Phoenix ICON wide-field infant fundus image
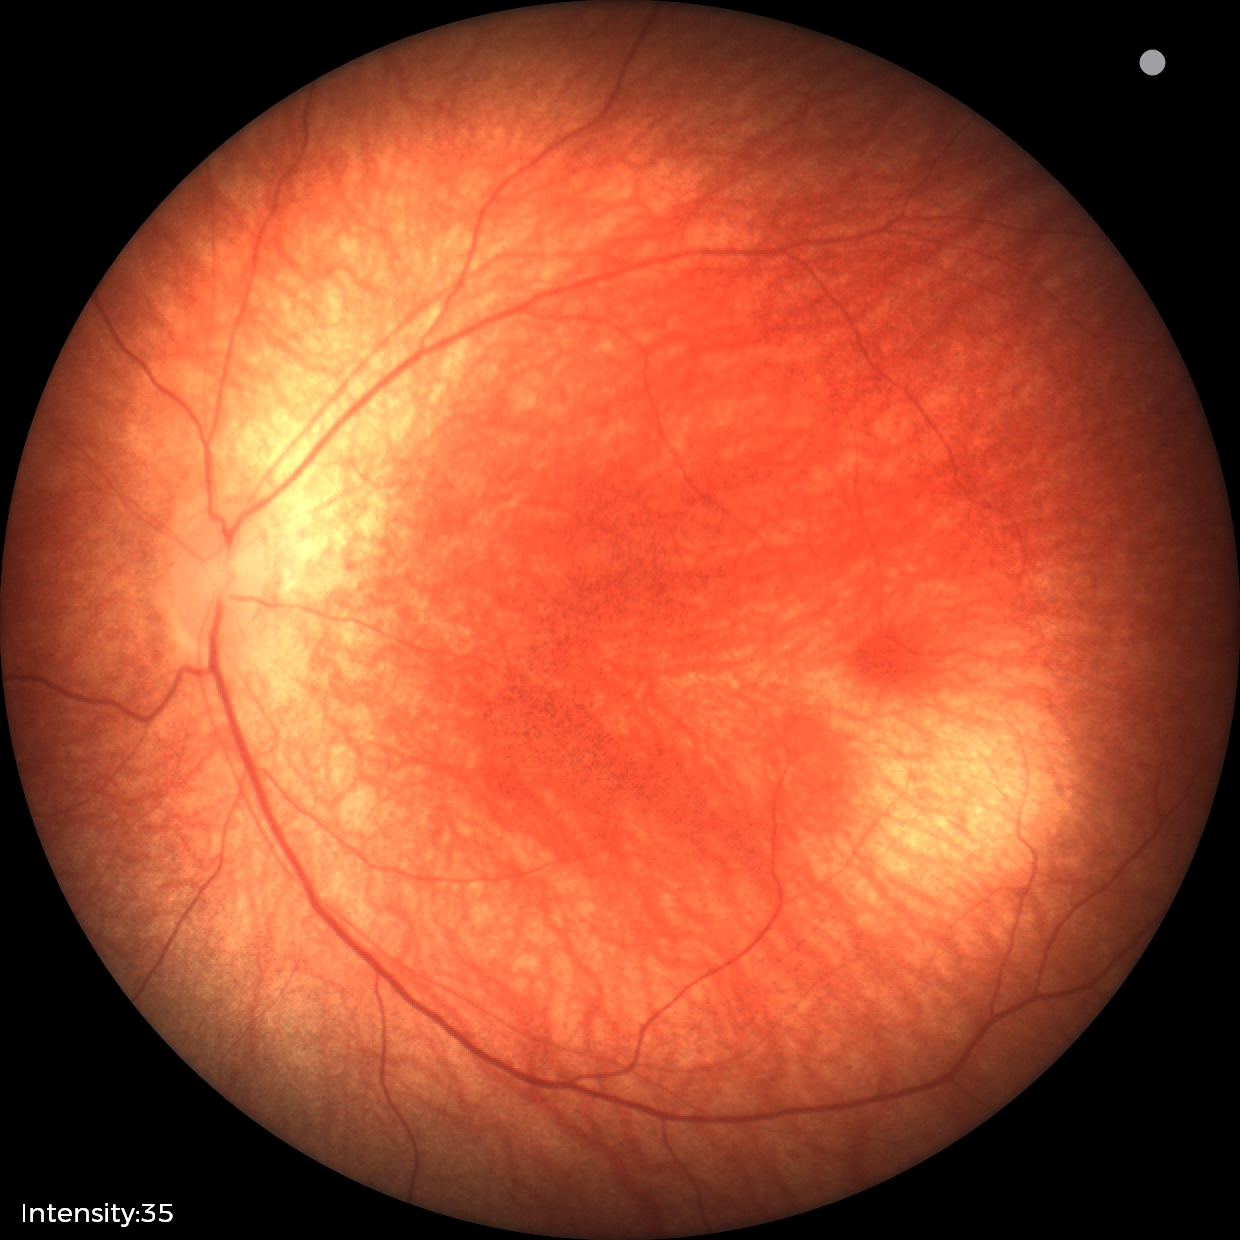 No retinal pathology identified on screening.